Graded on the modified Davis scale — 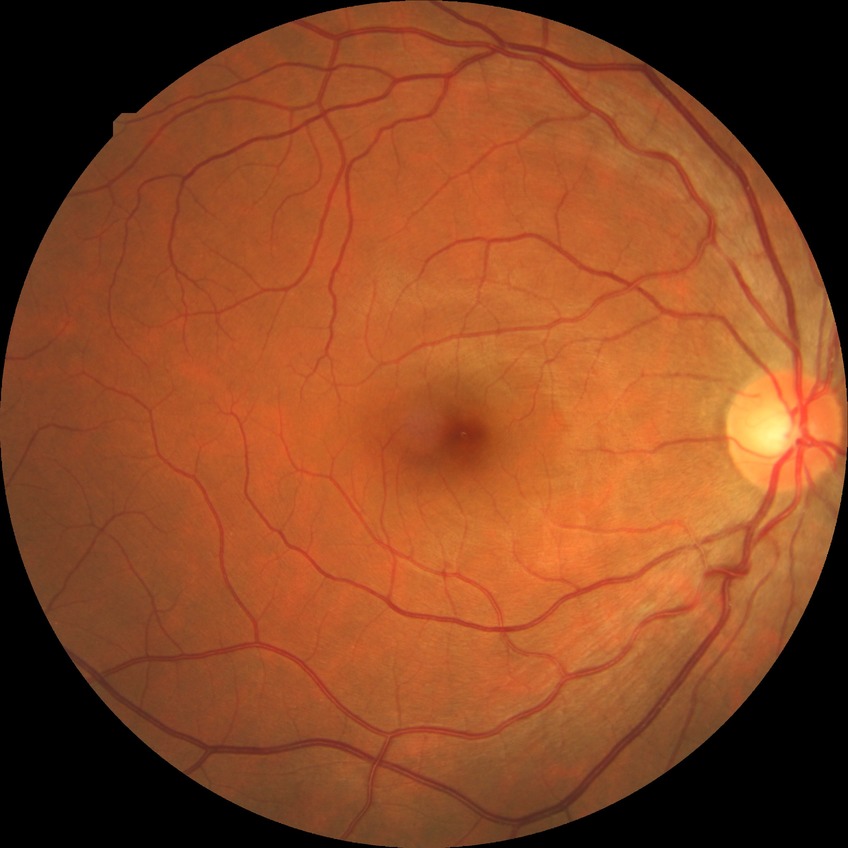

Findings:
– diabetic retinopathy (DR) — SDR (simple diabetic retinopathy)